Color fundus image. 512 x 512 pixels:
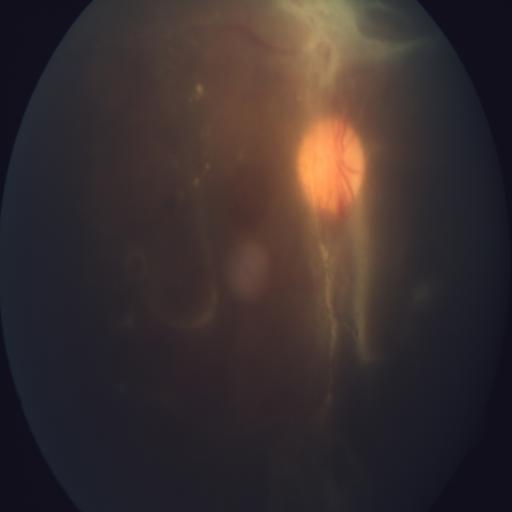
Demonstrates retinal traction.